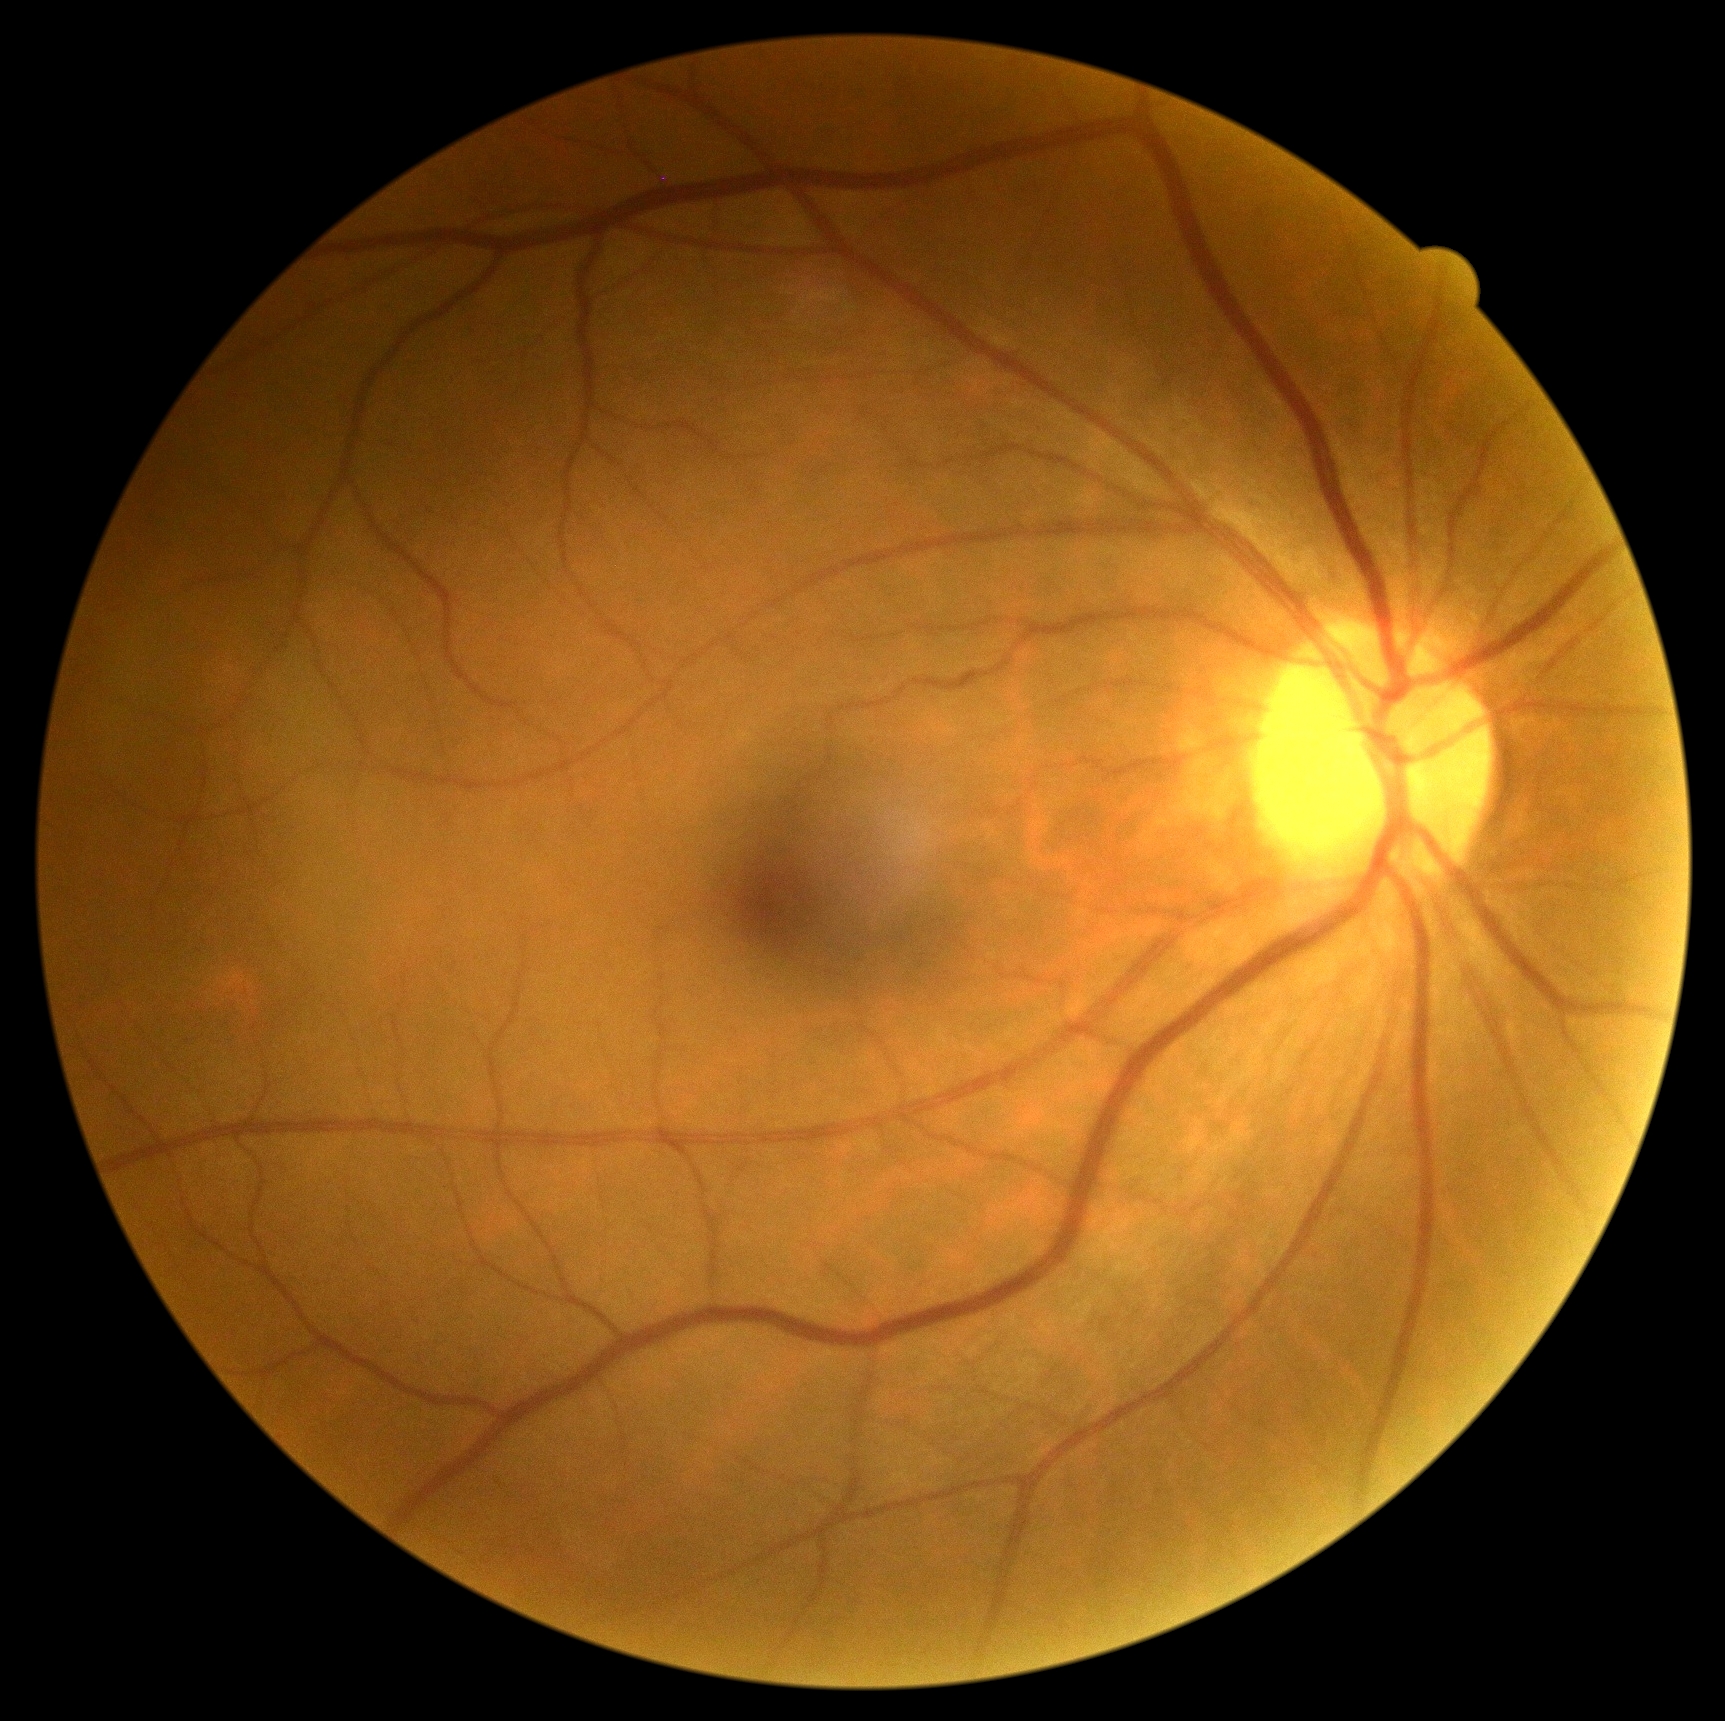 No diabetic retinal disease findings.
Retinopathy: grade 0 (no apparent retinopathy).